Graded on the modified Davis scale:
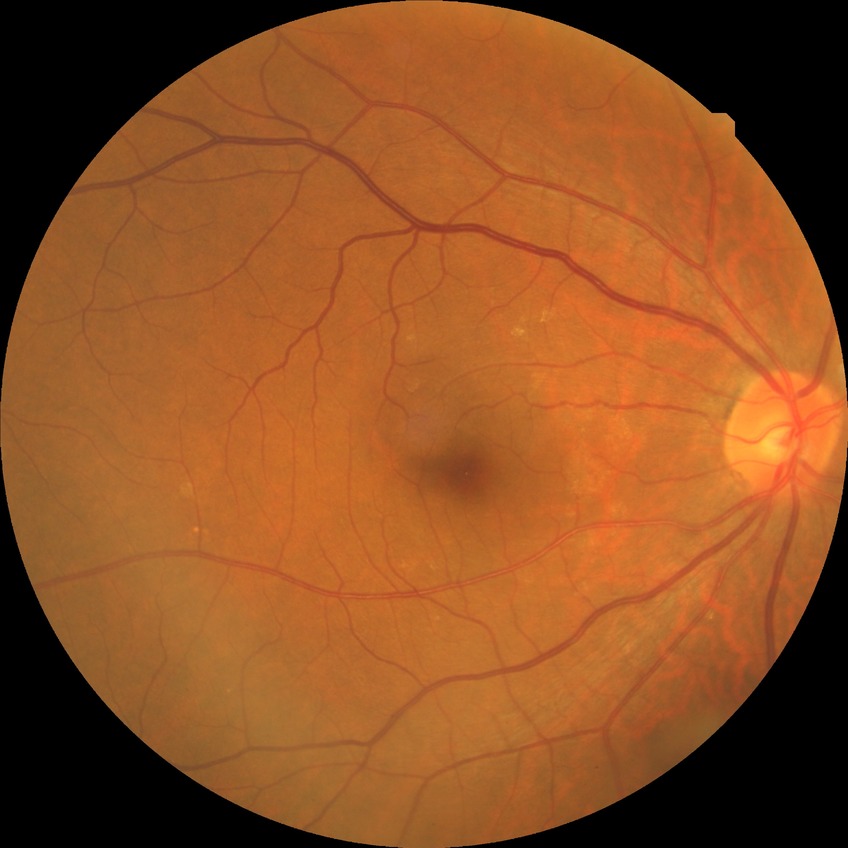 Diabetic retinopathy (DR) is no diabetic retinopathy (NDR).